Image size 848x848 · color fundus photograph · 45° field of view · NIDEK AFC-230 fundus camera: 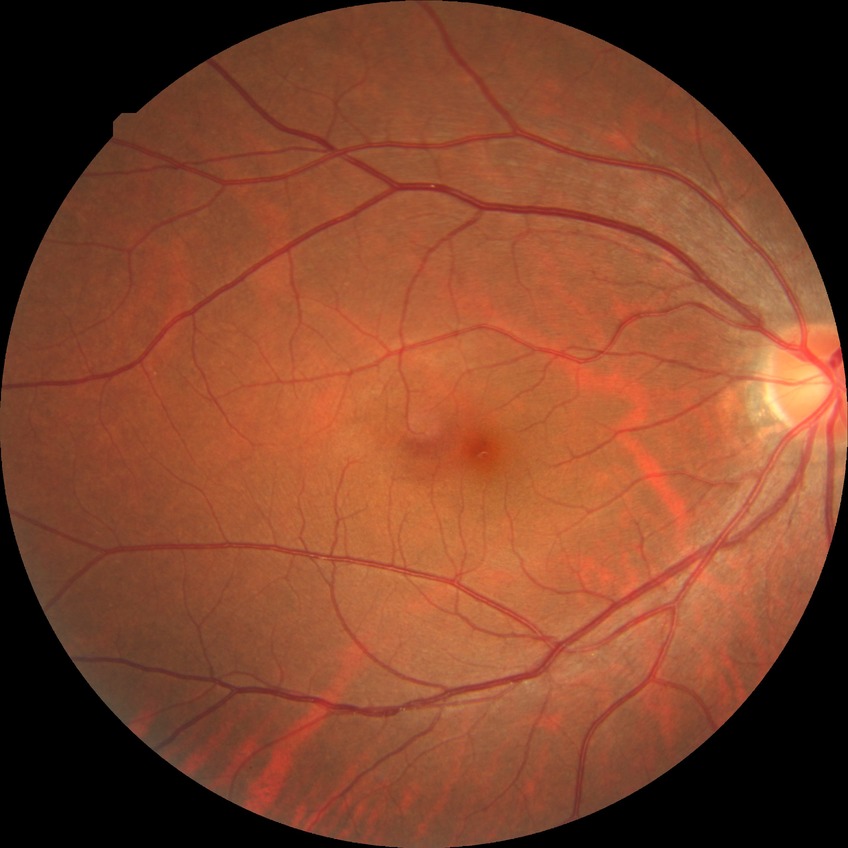
Annotations:
• diabetic retinopathy (DR): NDR (no diabetic retinopathy)